Color fundus photograph
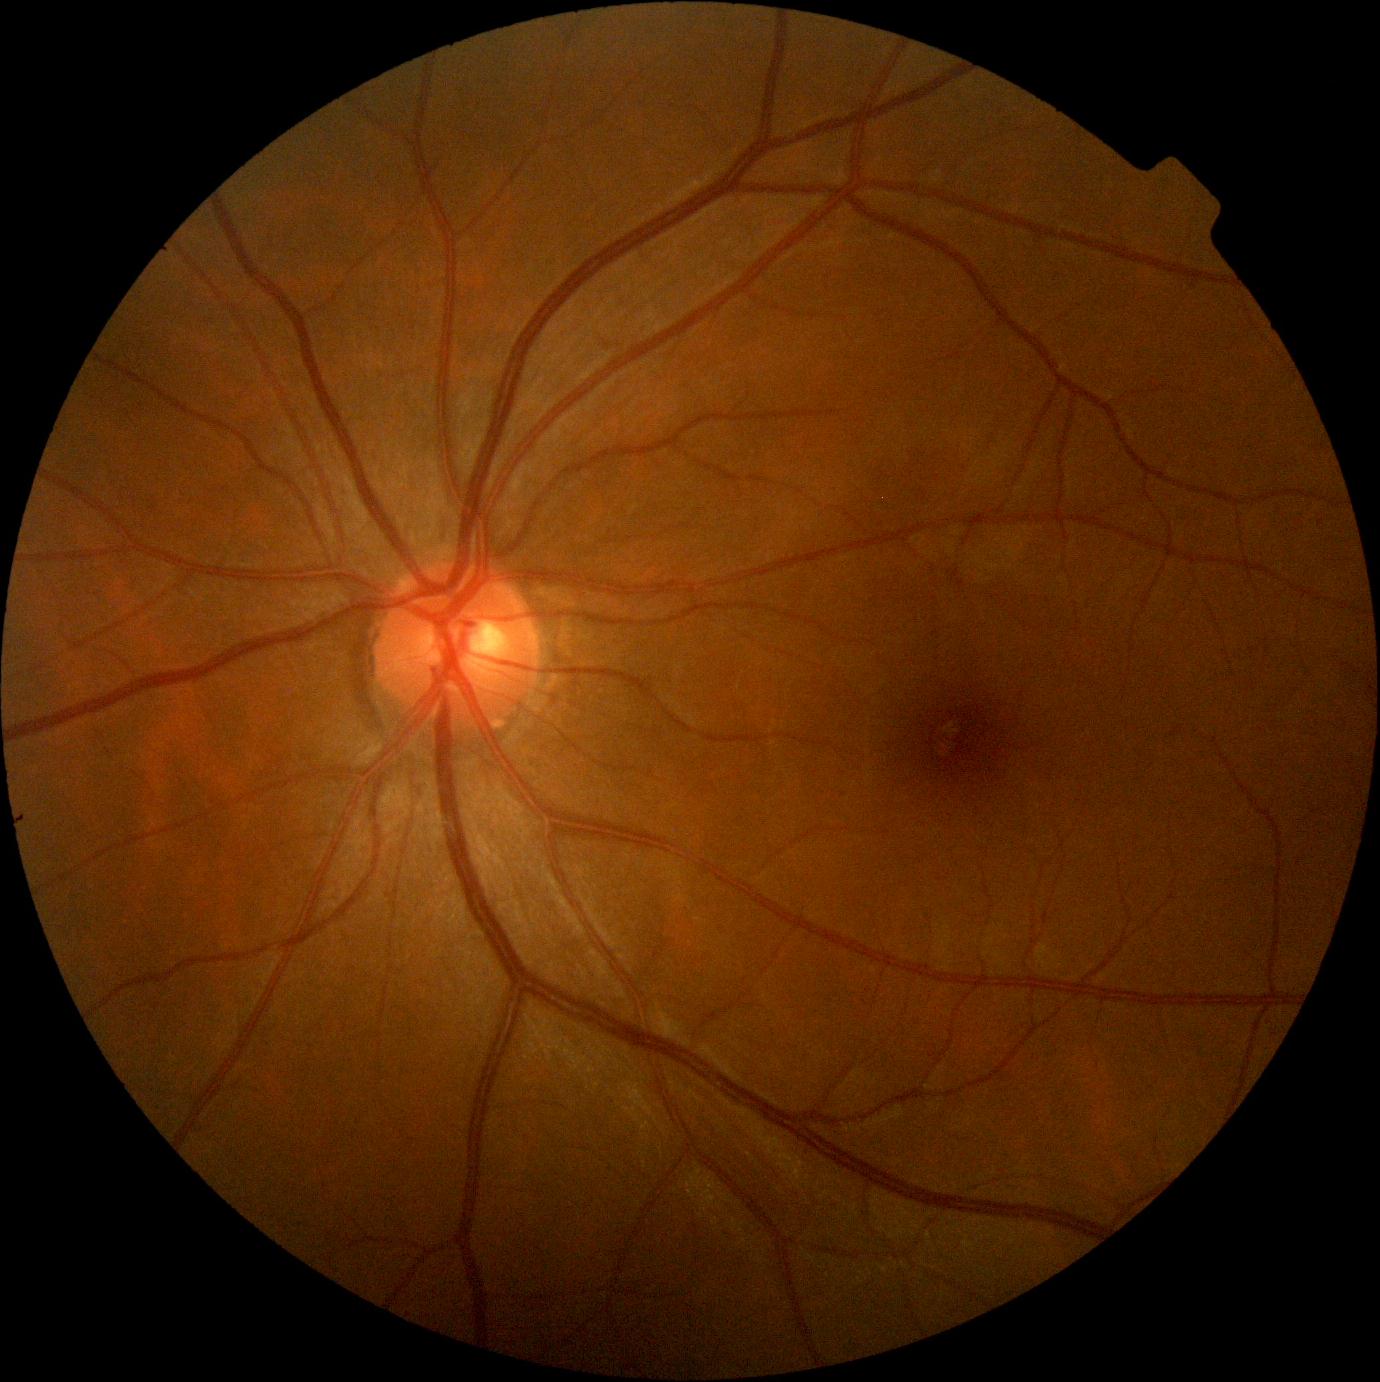
Findings:
- DR grade — 0 — no visible signs of diabetic retinopathy
- DR impression — negative for DR